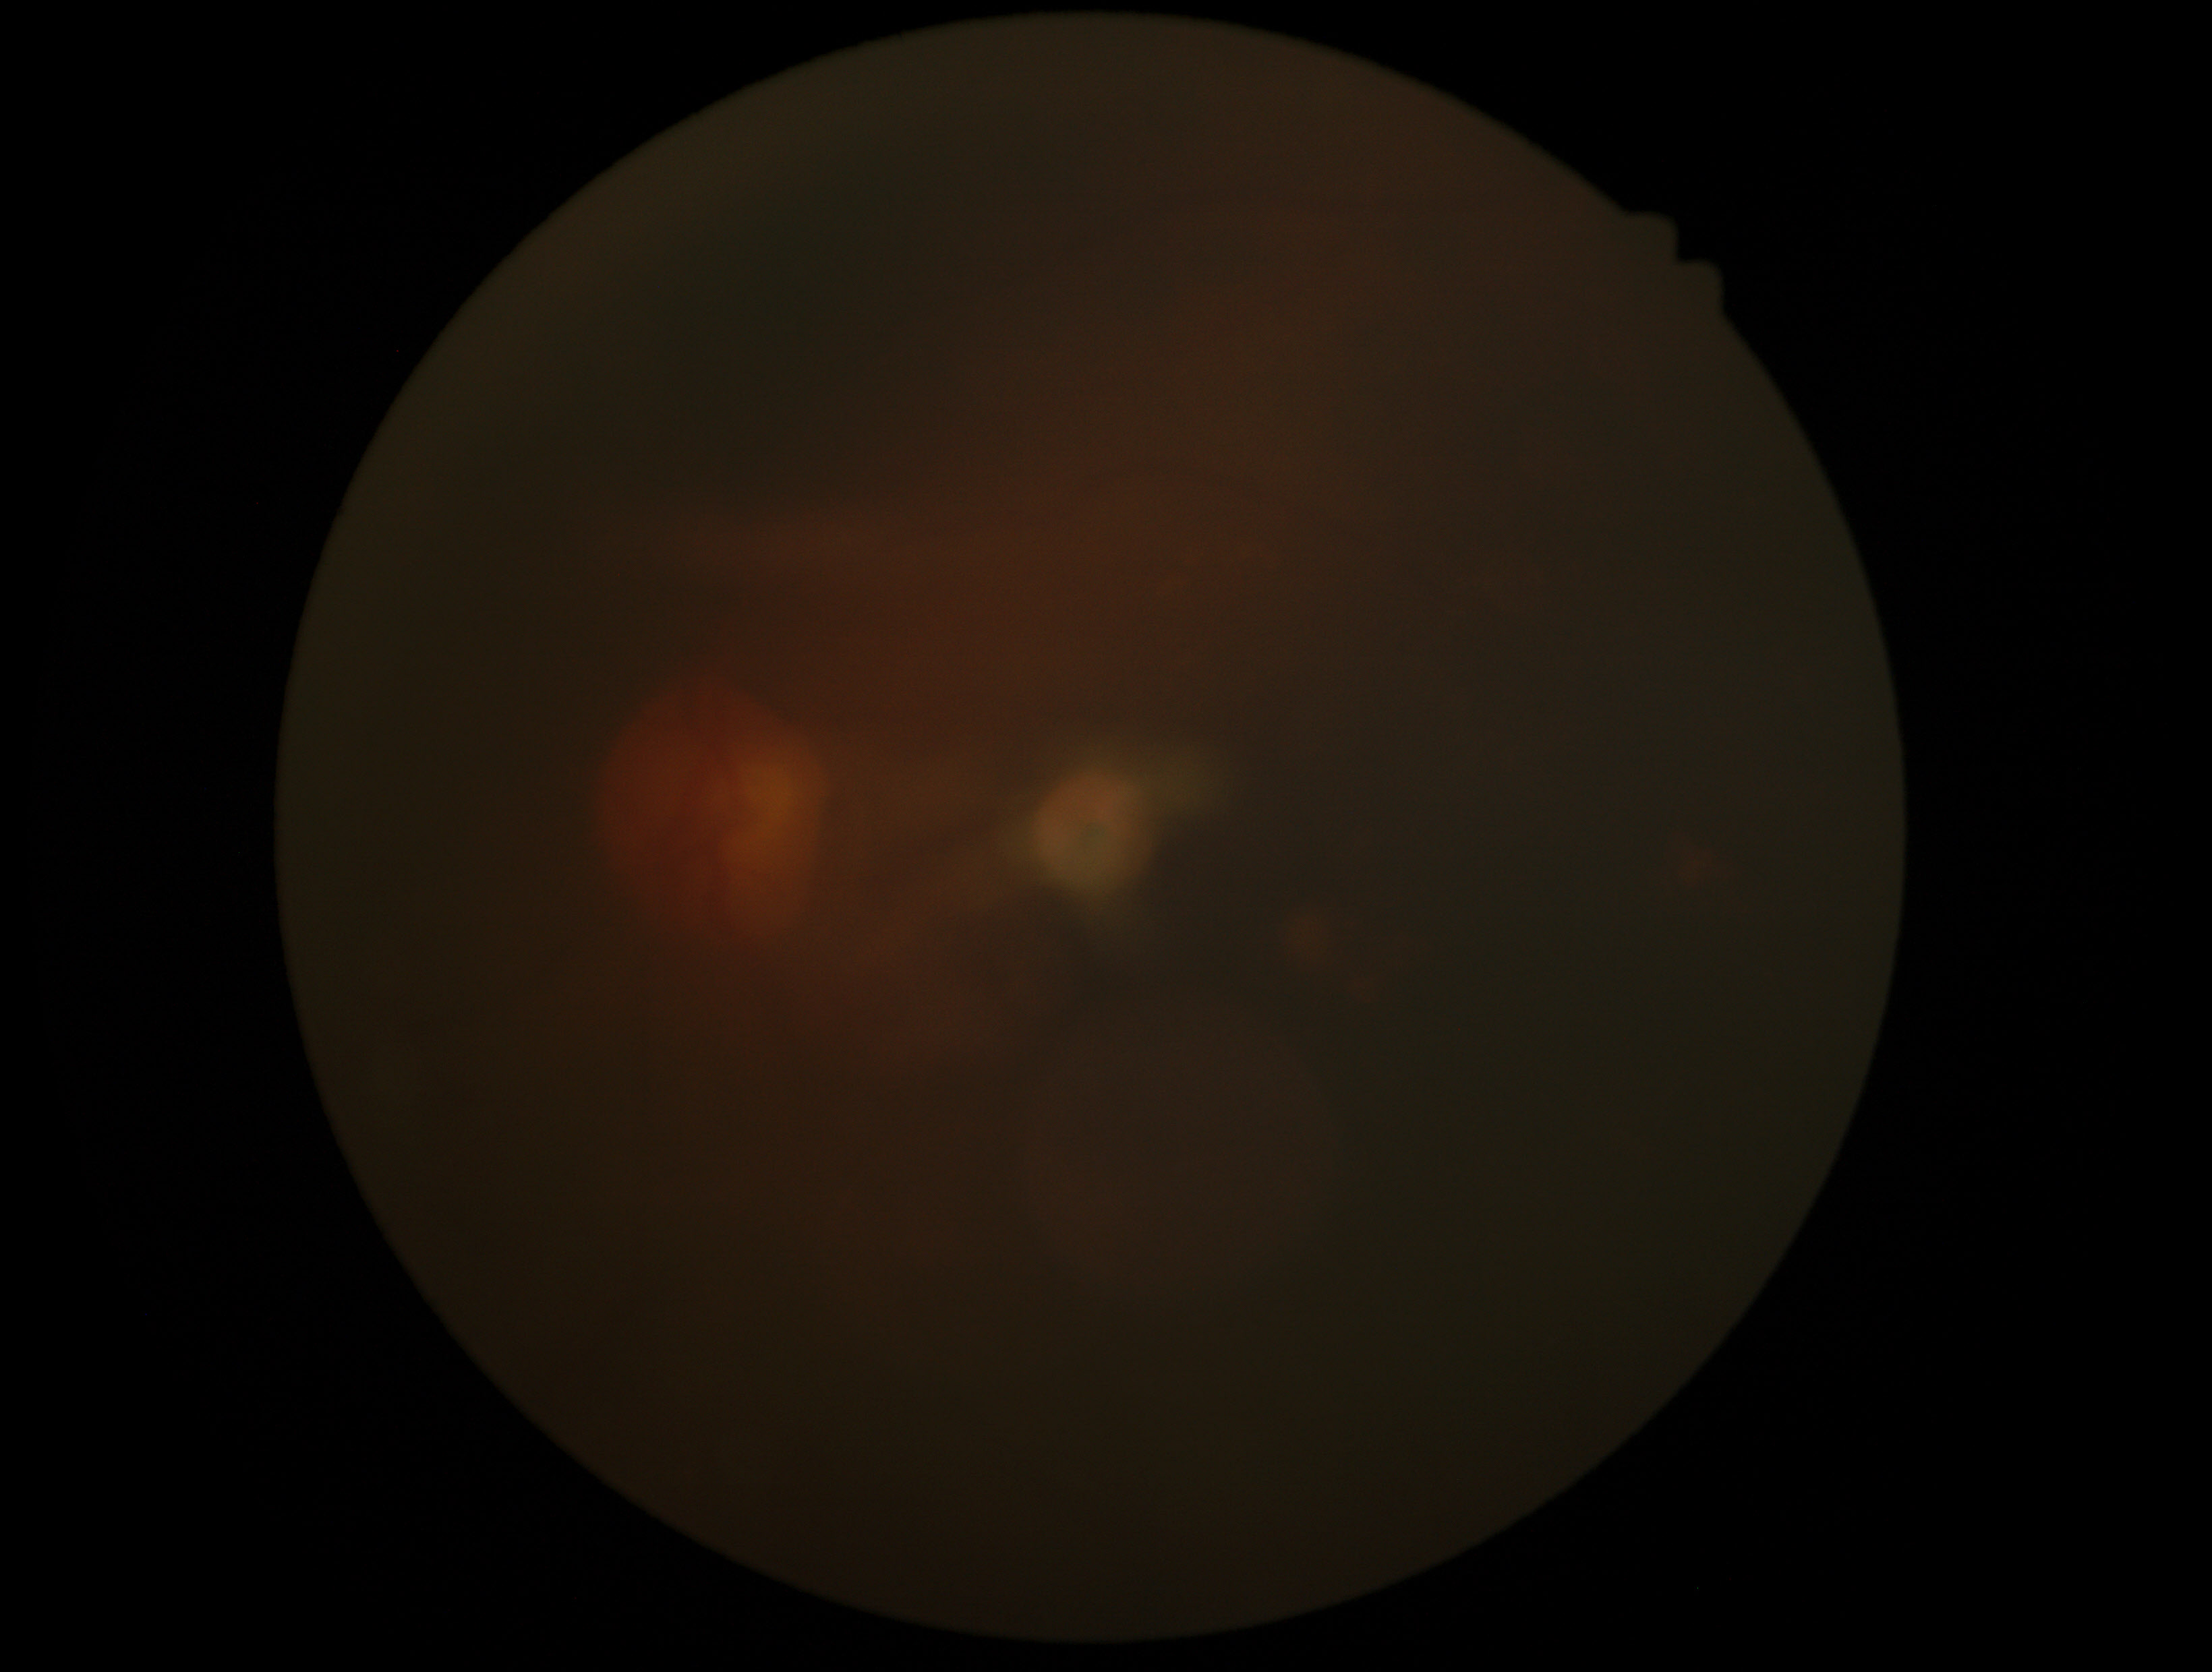

Diabetic retinopathy (DR) is ungradable due to poor image quality.